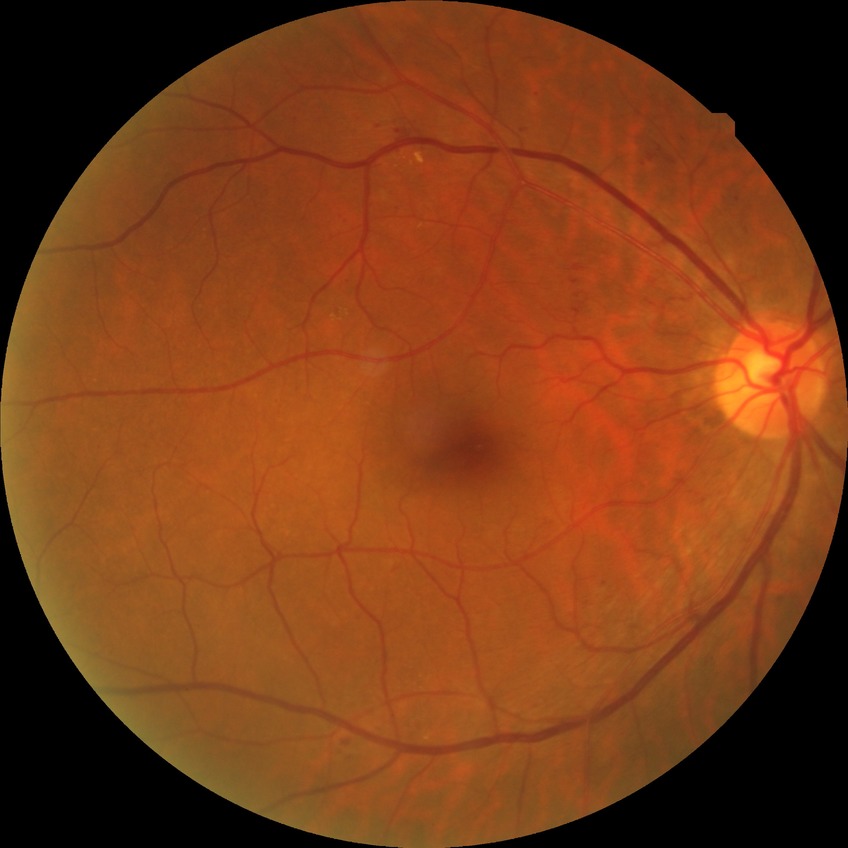

Diabetic retinopathy (DR) is simple diabetic retinopathy (SDR).